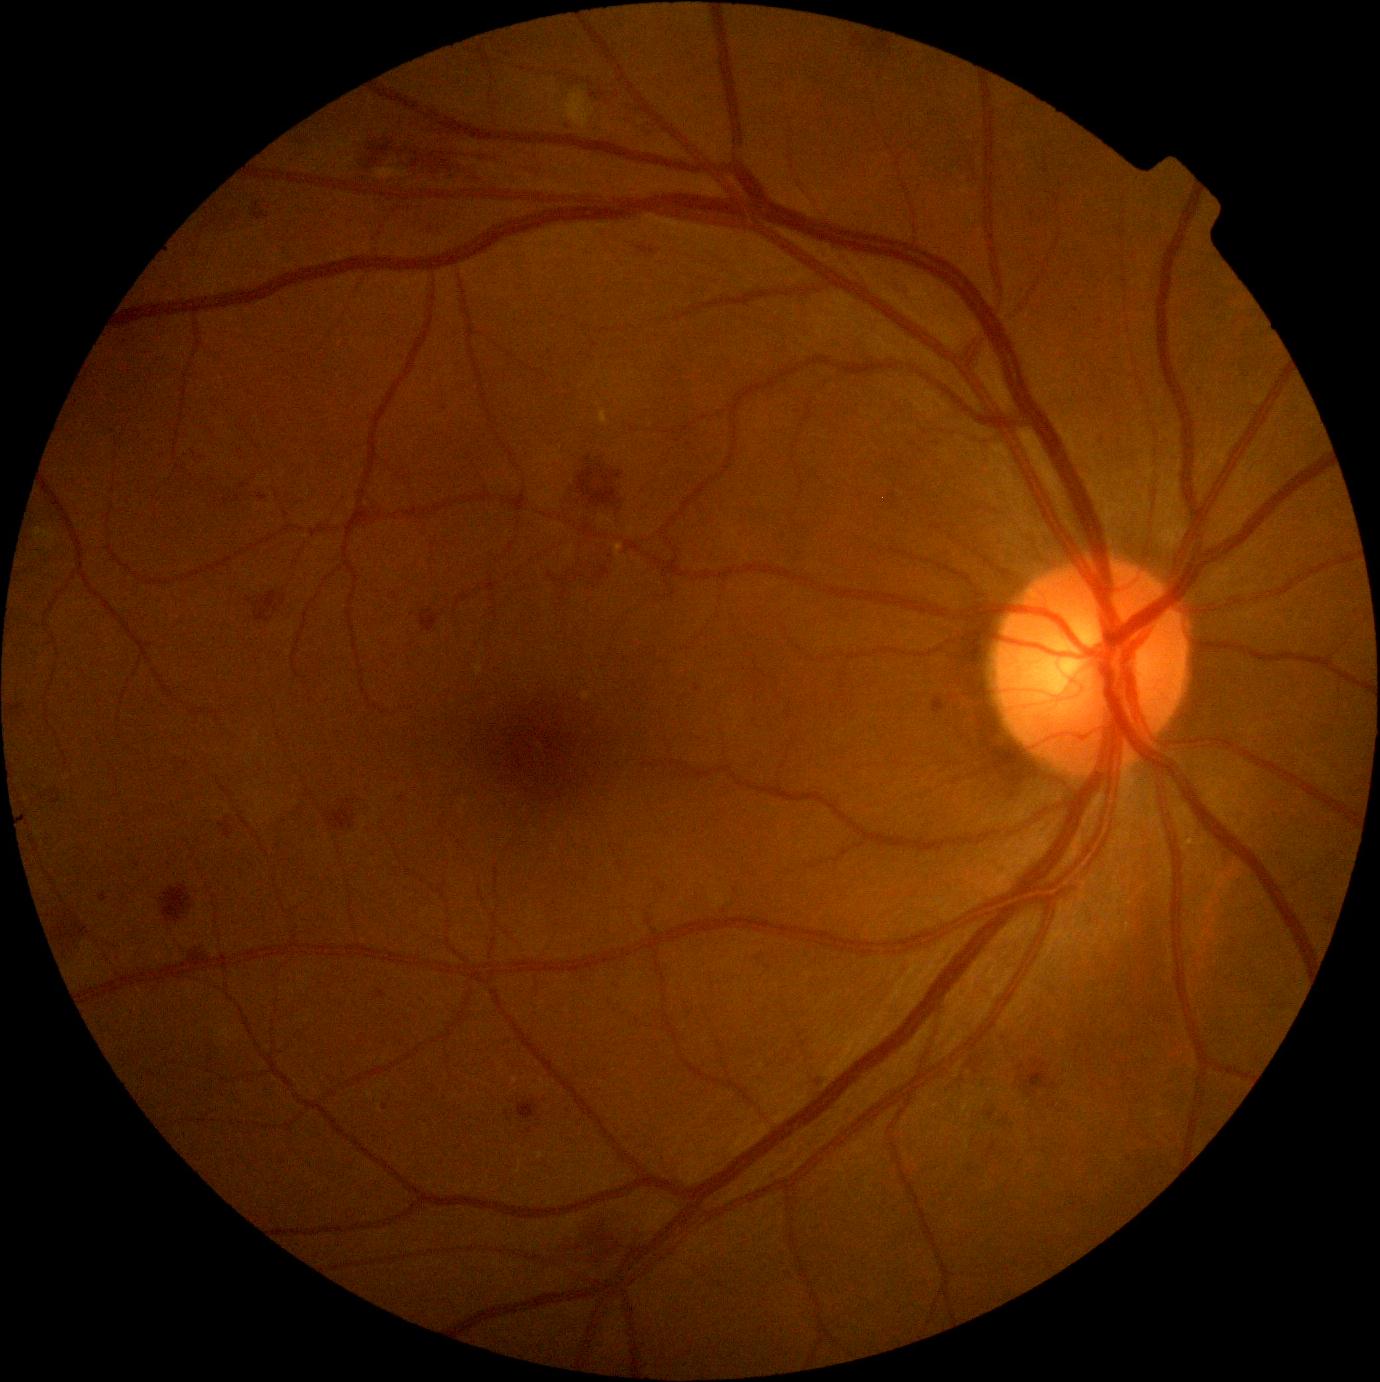
DR stage: 2.